FOV: 45 degrees:
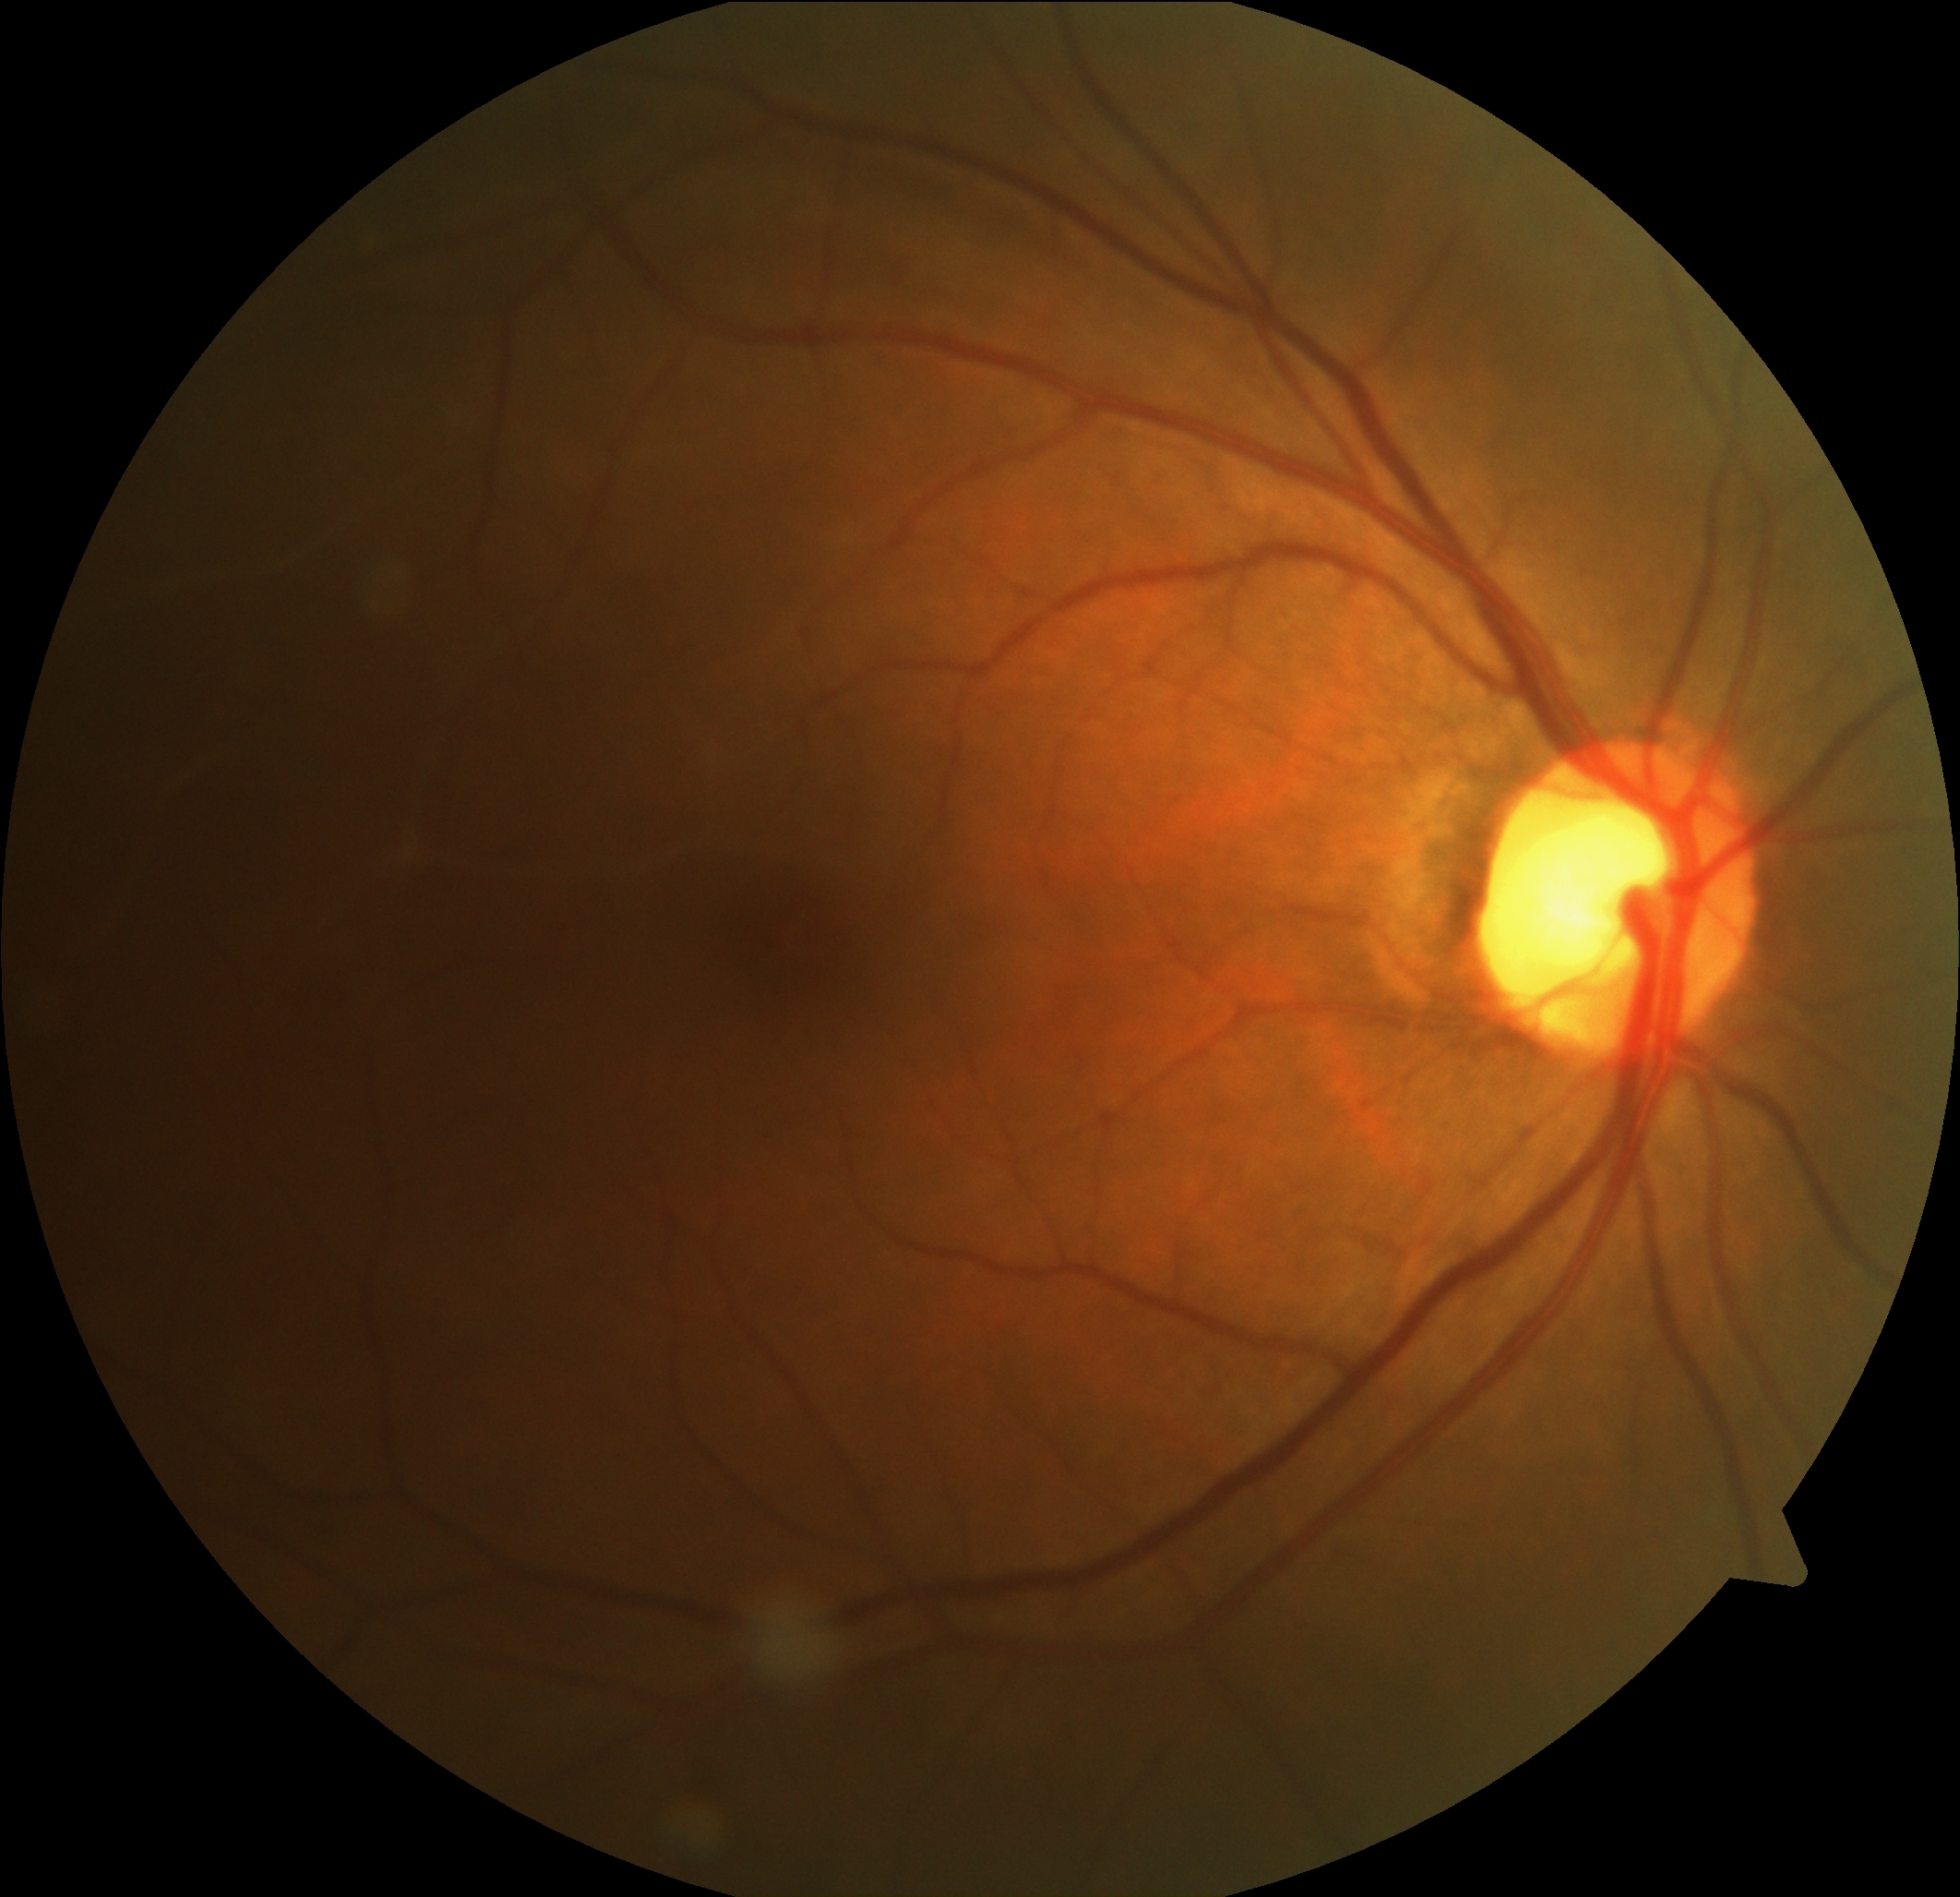
DR is 0.